Image size 848x848, modified Davis grading, NIDEK AFC-230, FOV: 45 degrees:
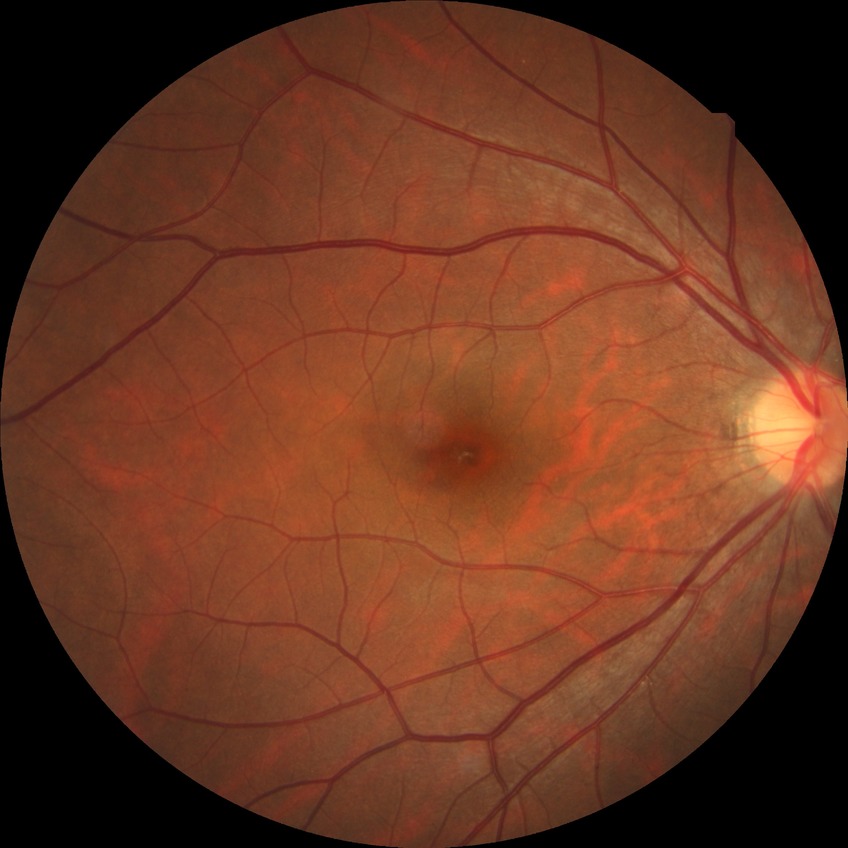
  davis_grade: no diabetic retinopathy (NDR)